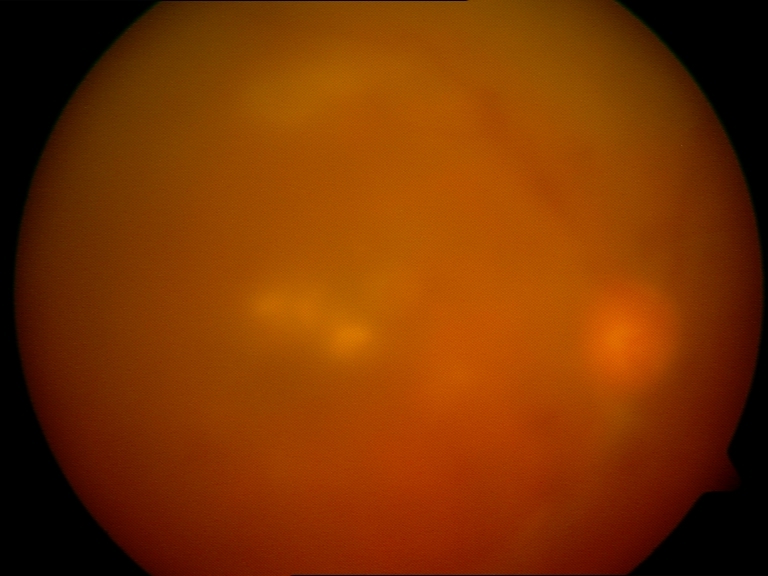
Image is blurred; retinal landmarks are largely obscured. No proliferative diabetic retinopathy identified.